Acquired with a NIDEK AFC-230 · FOV: 45 degrees.
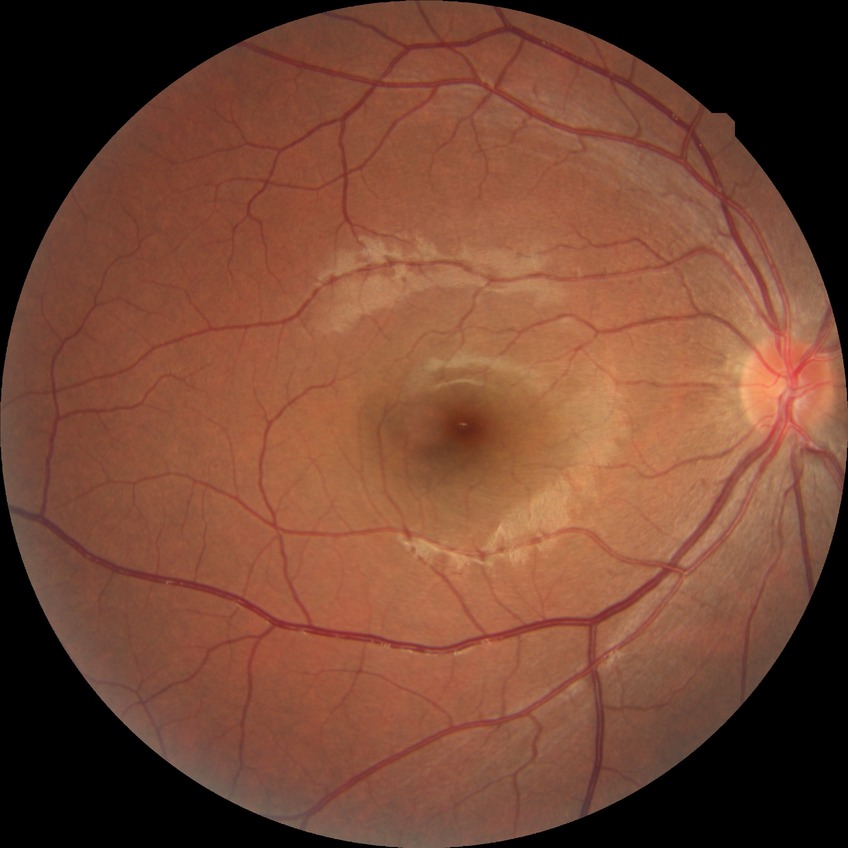

  davis_grade: NDR